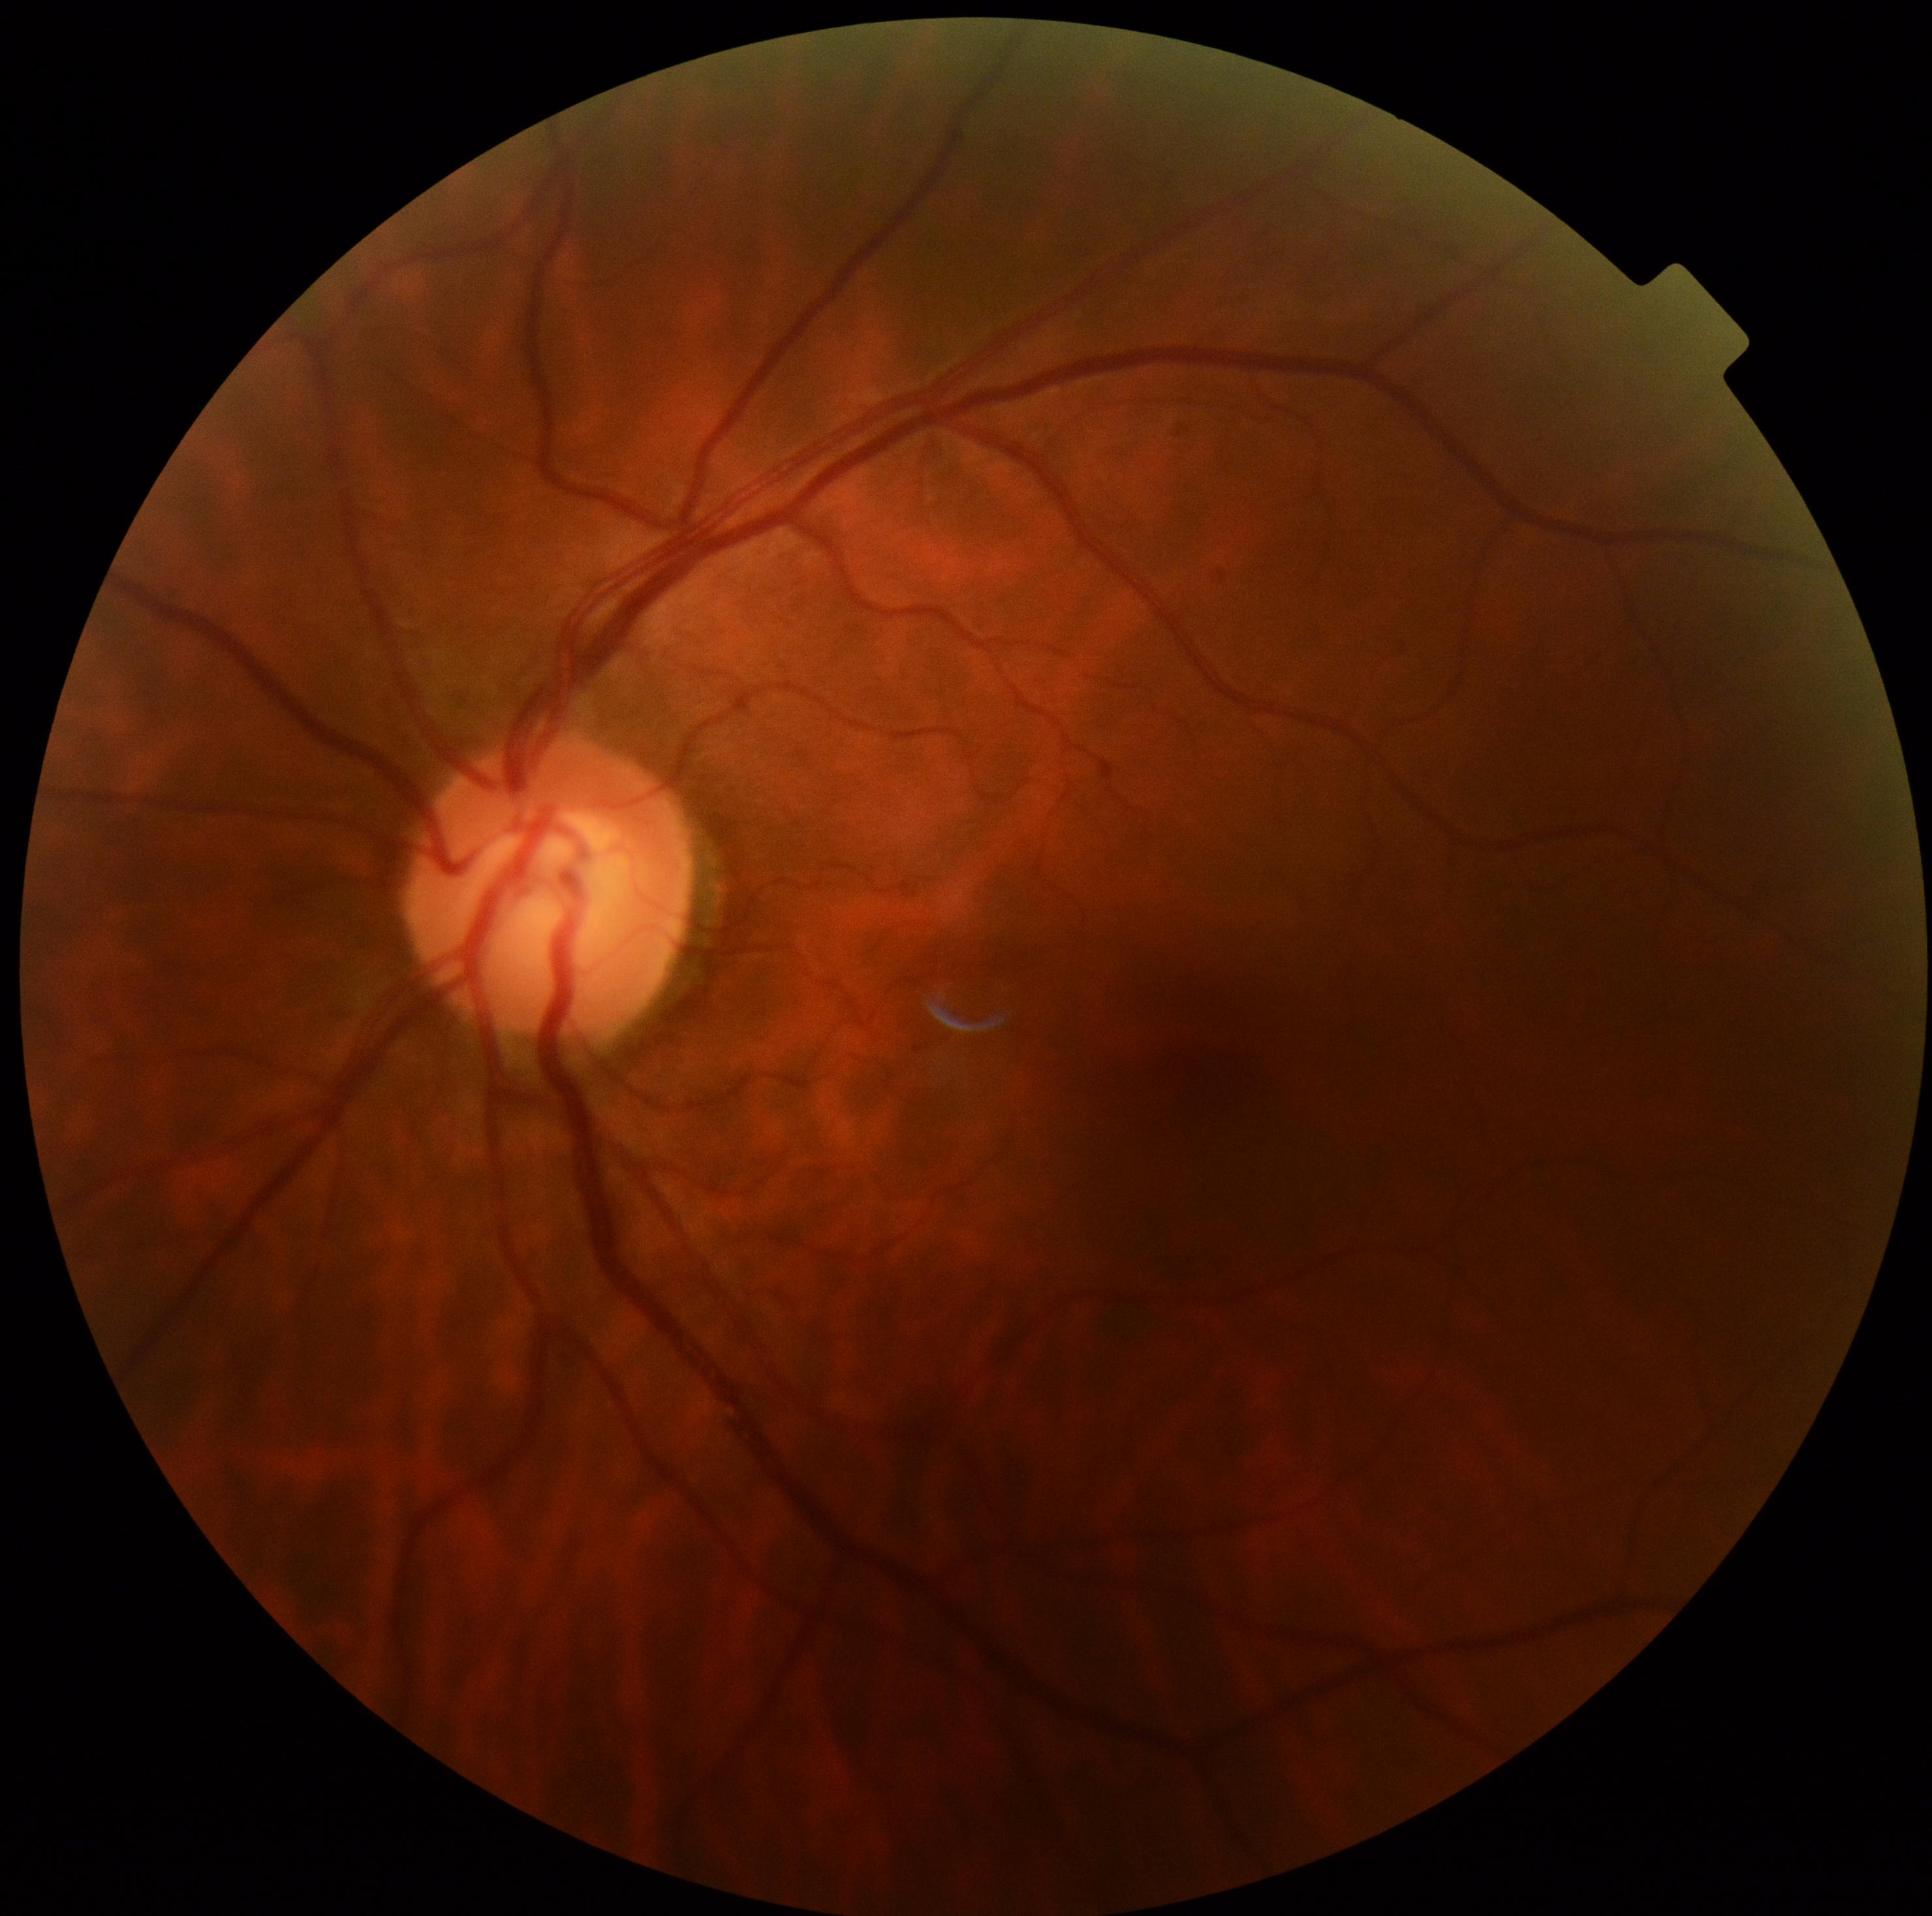 DR: grade 0 — no visible signs of diabetic retinopathy. No apparent diabetic retinopathy.